Retinal fundus photograph
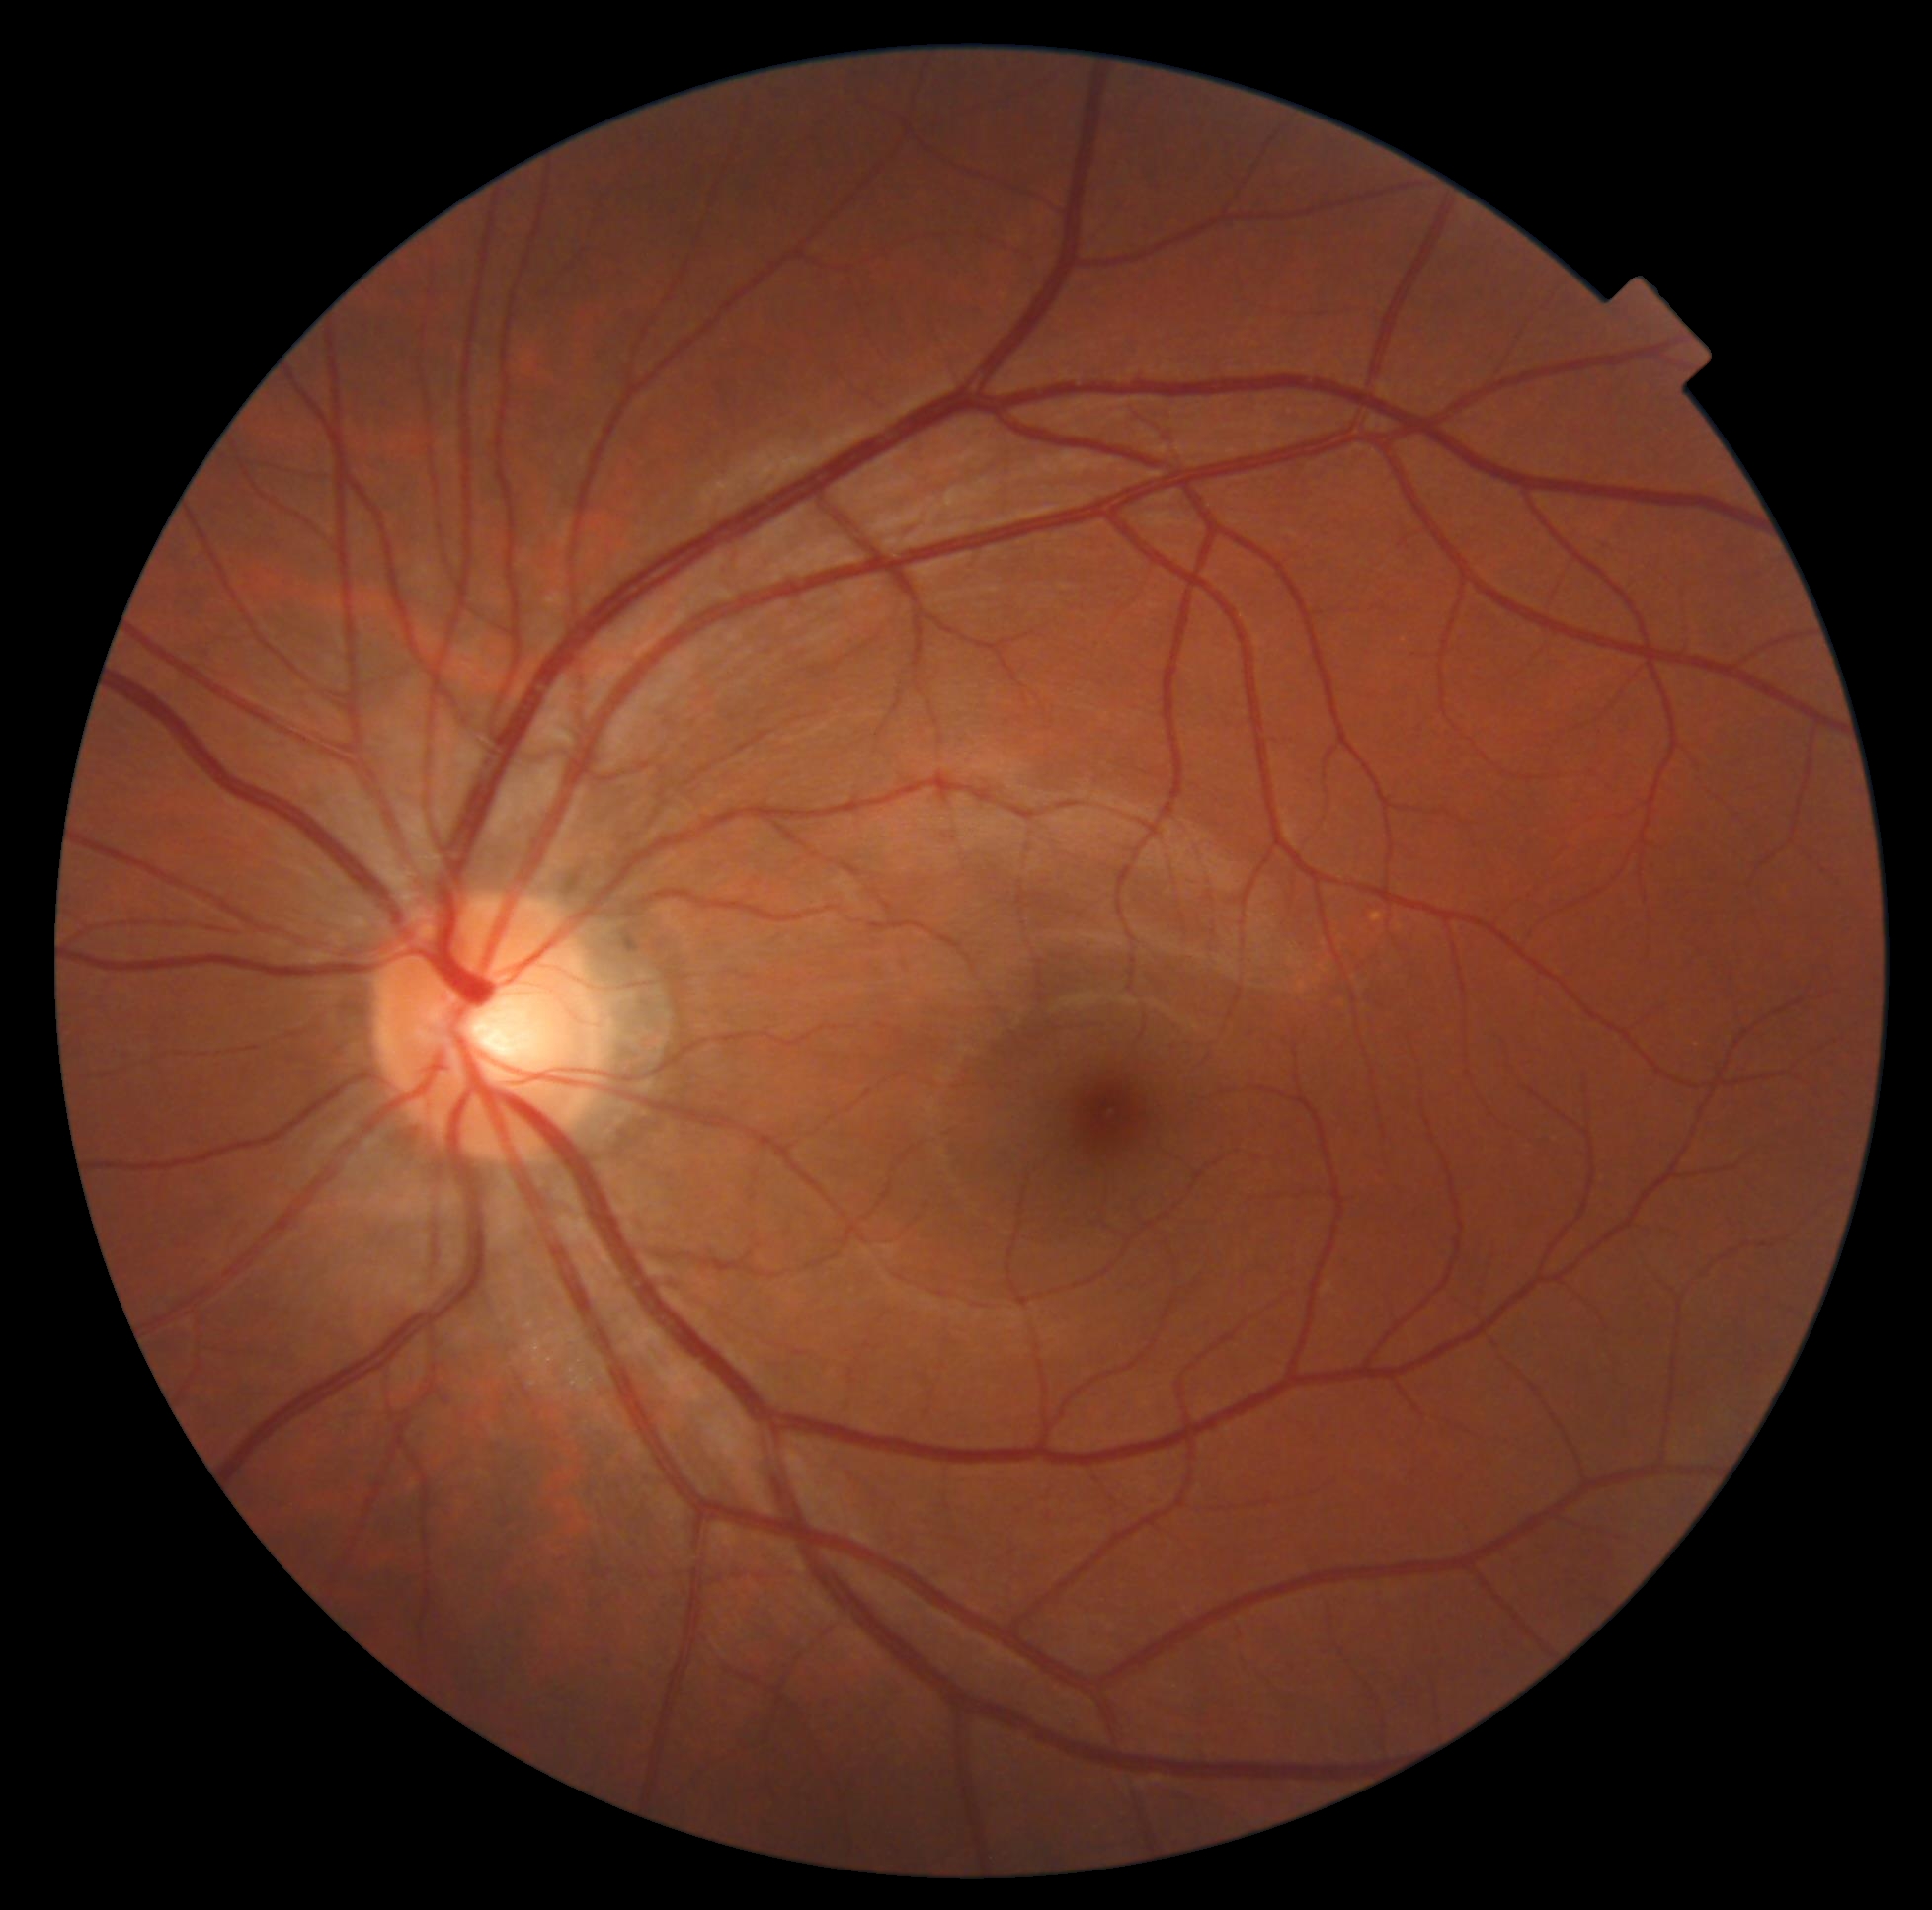

DR stage is no apparent diabetic retinopathy (grade 0).